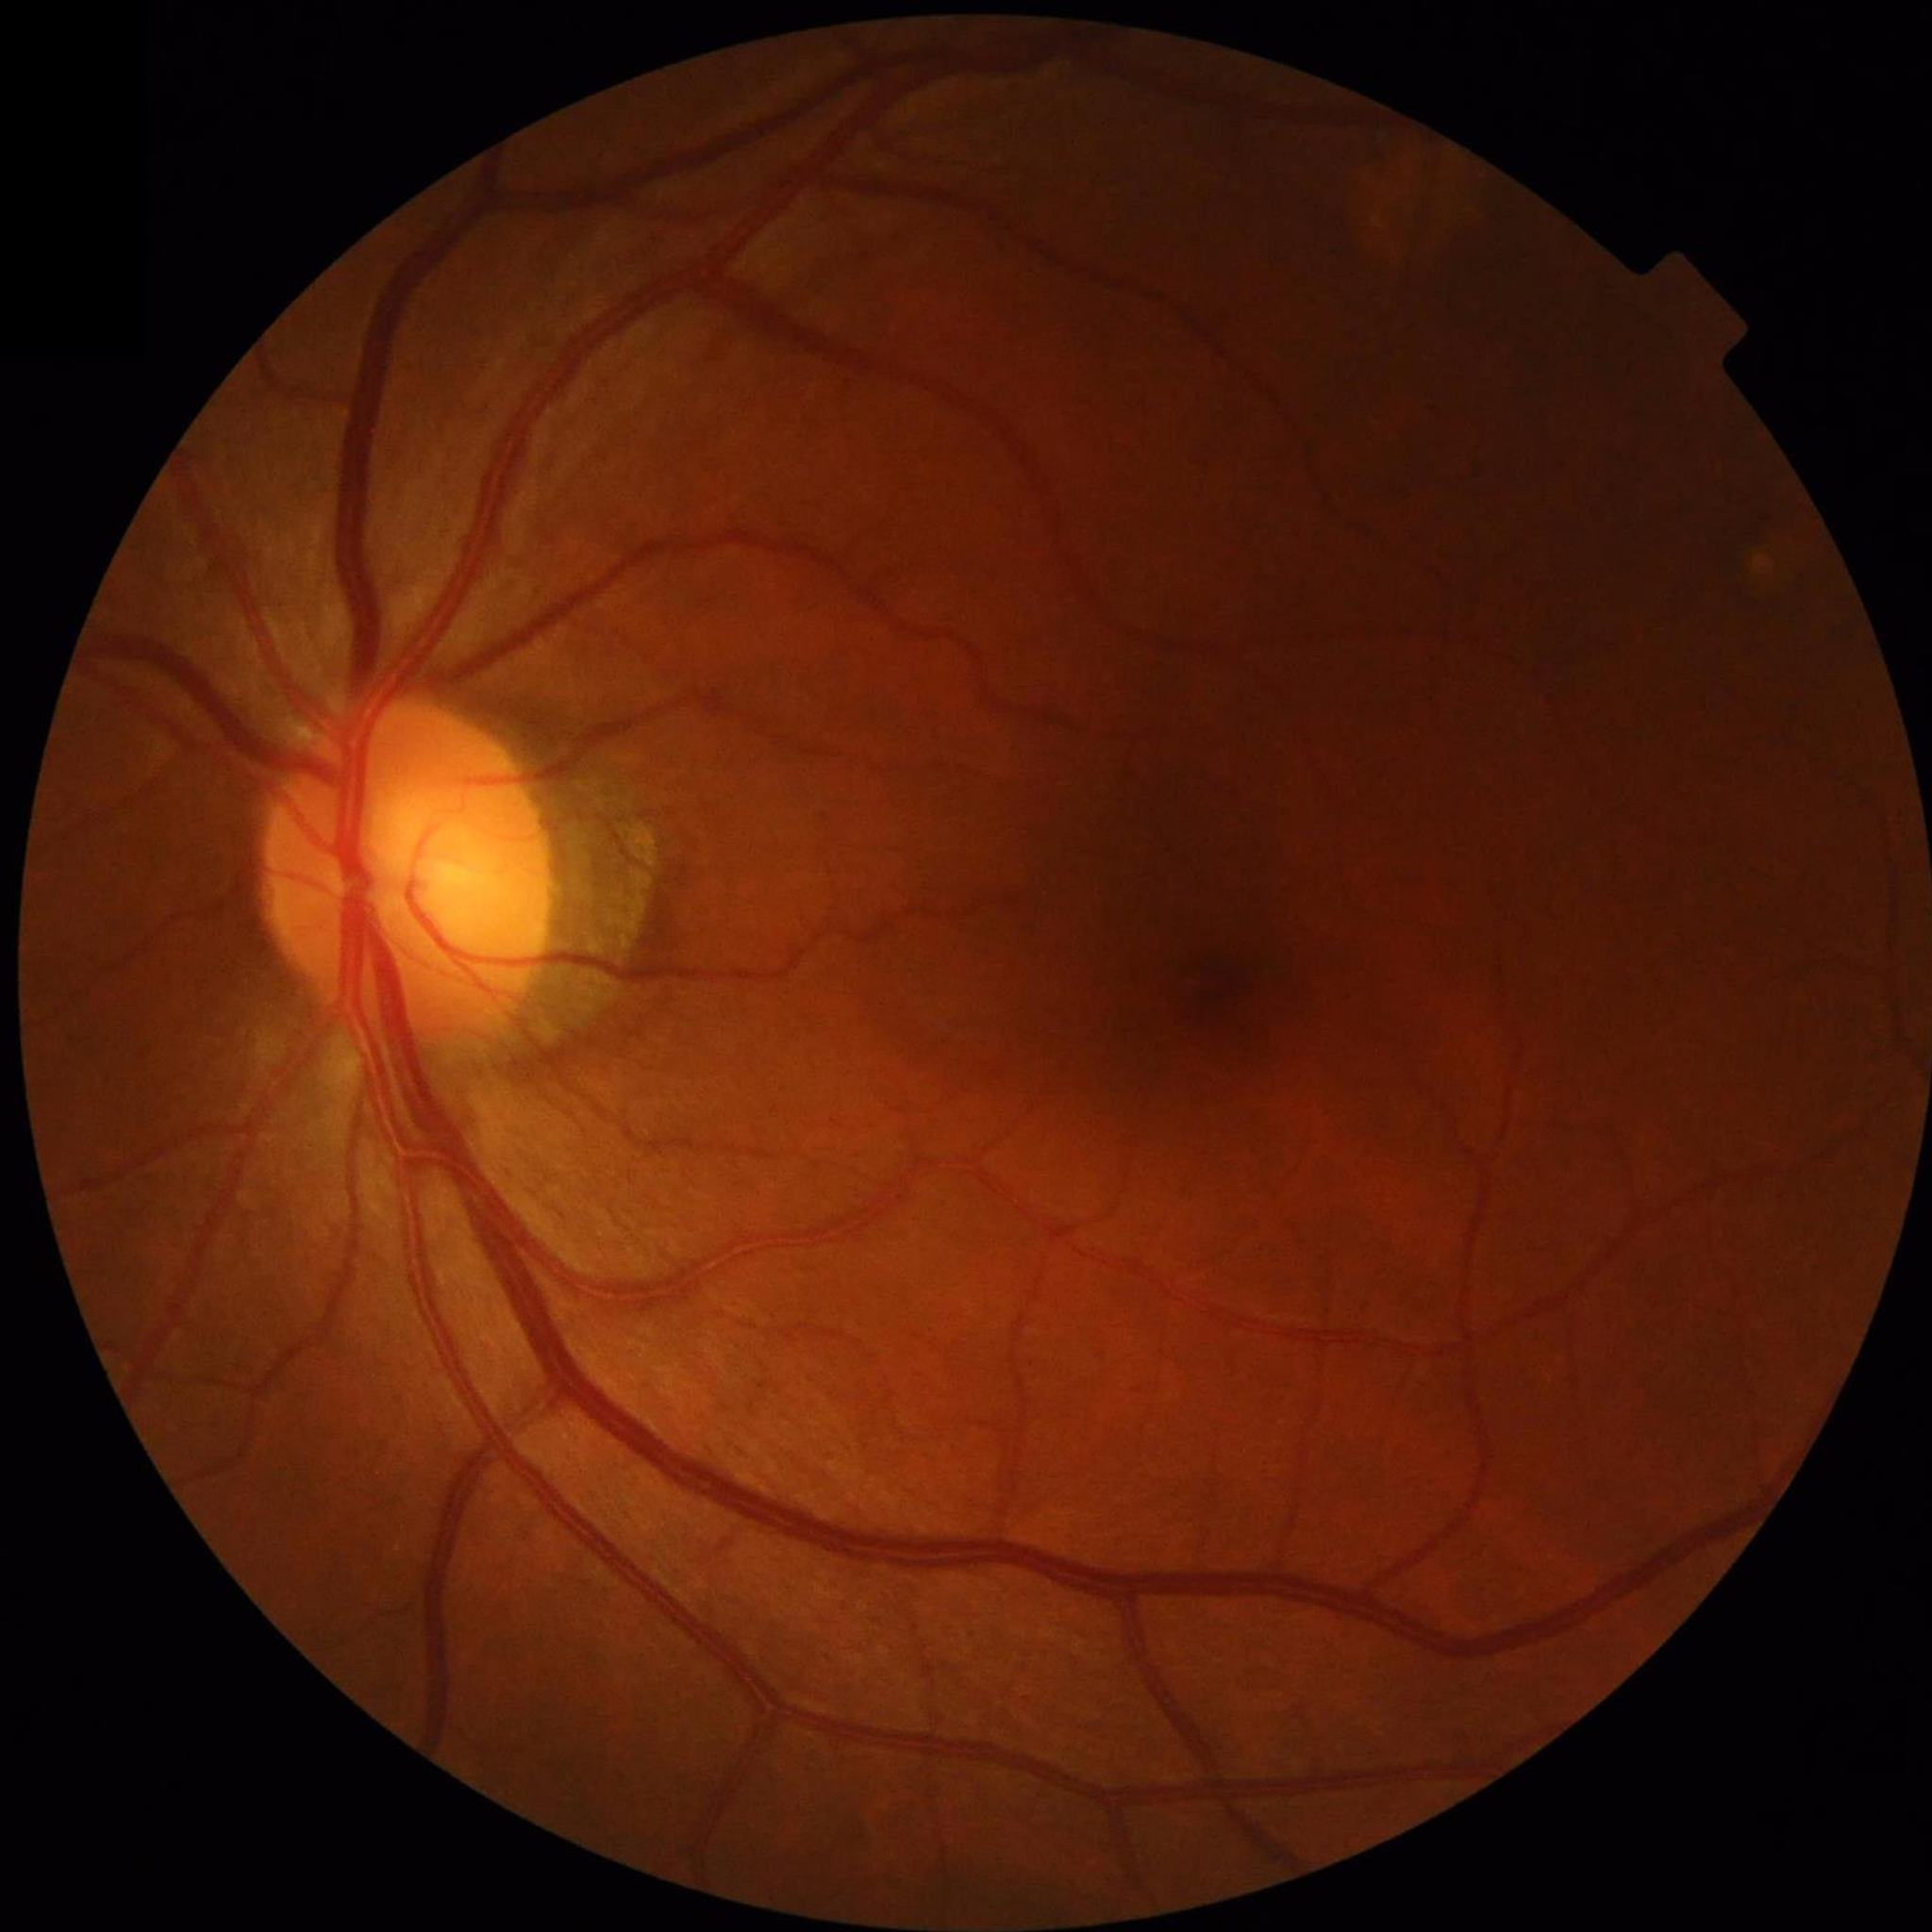

Color fundus photo from a control patient without diagnosed retinal disease.